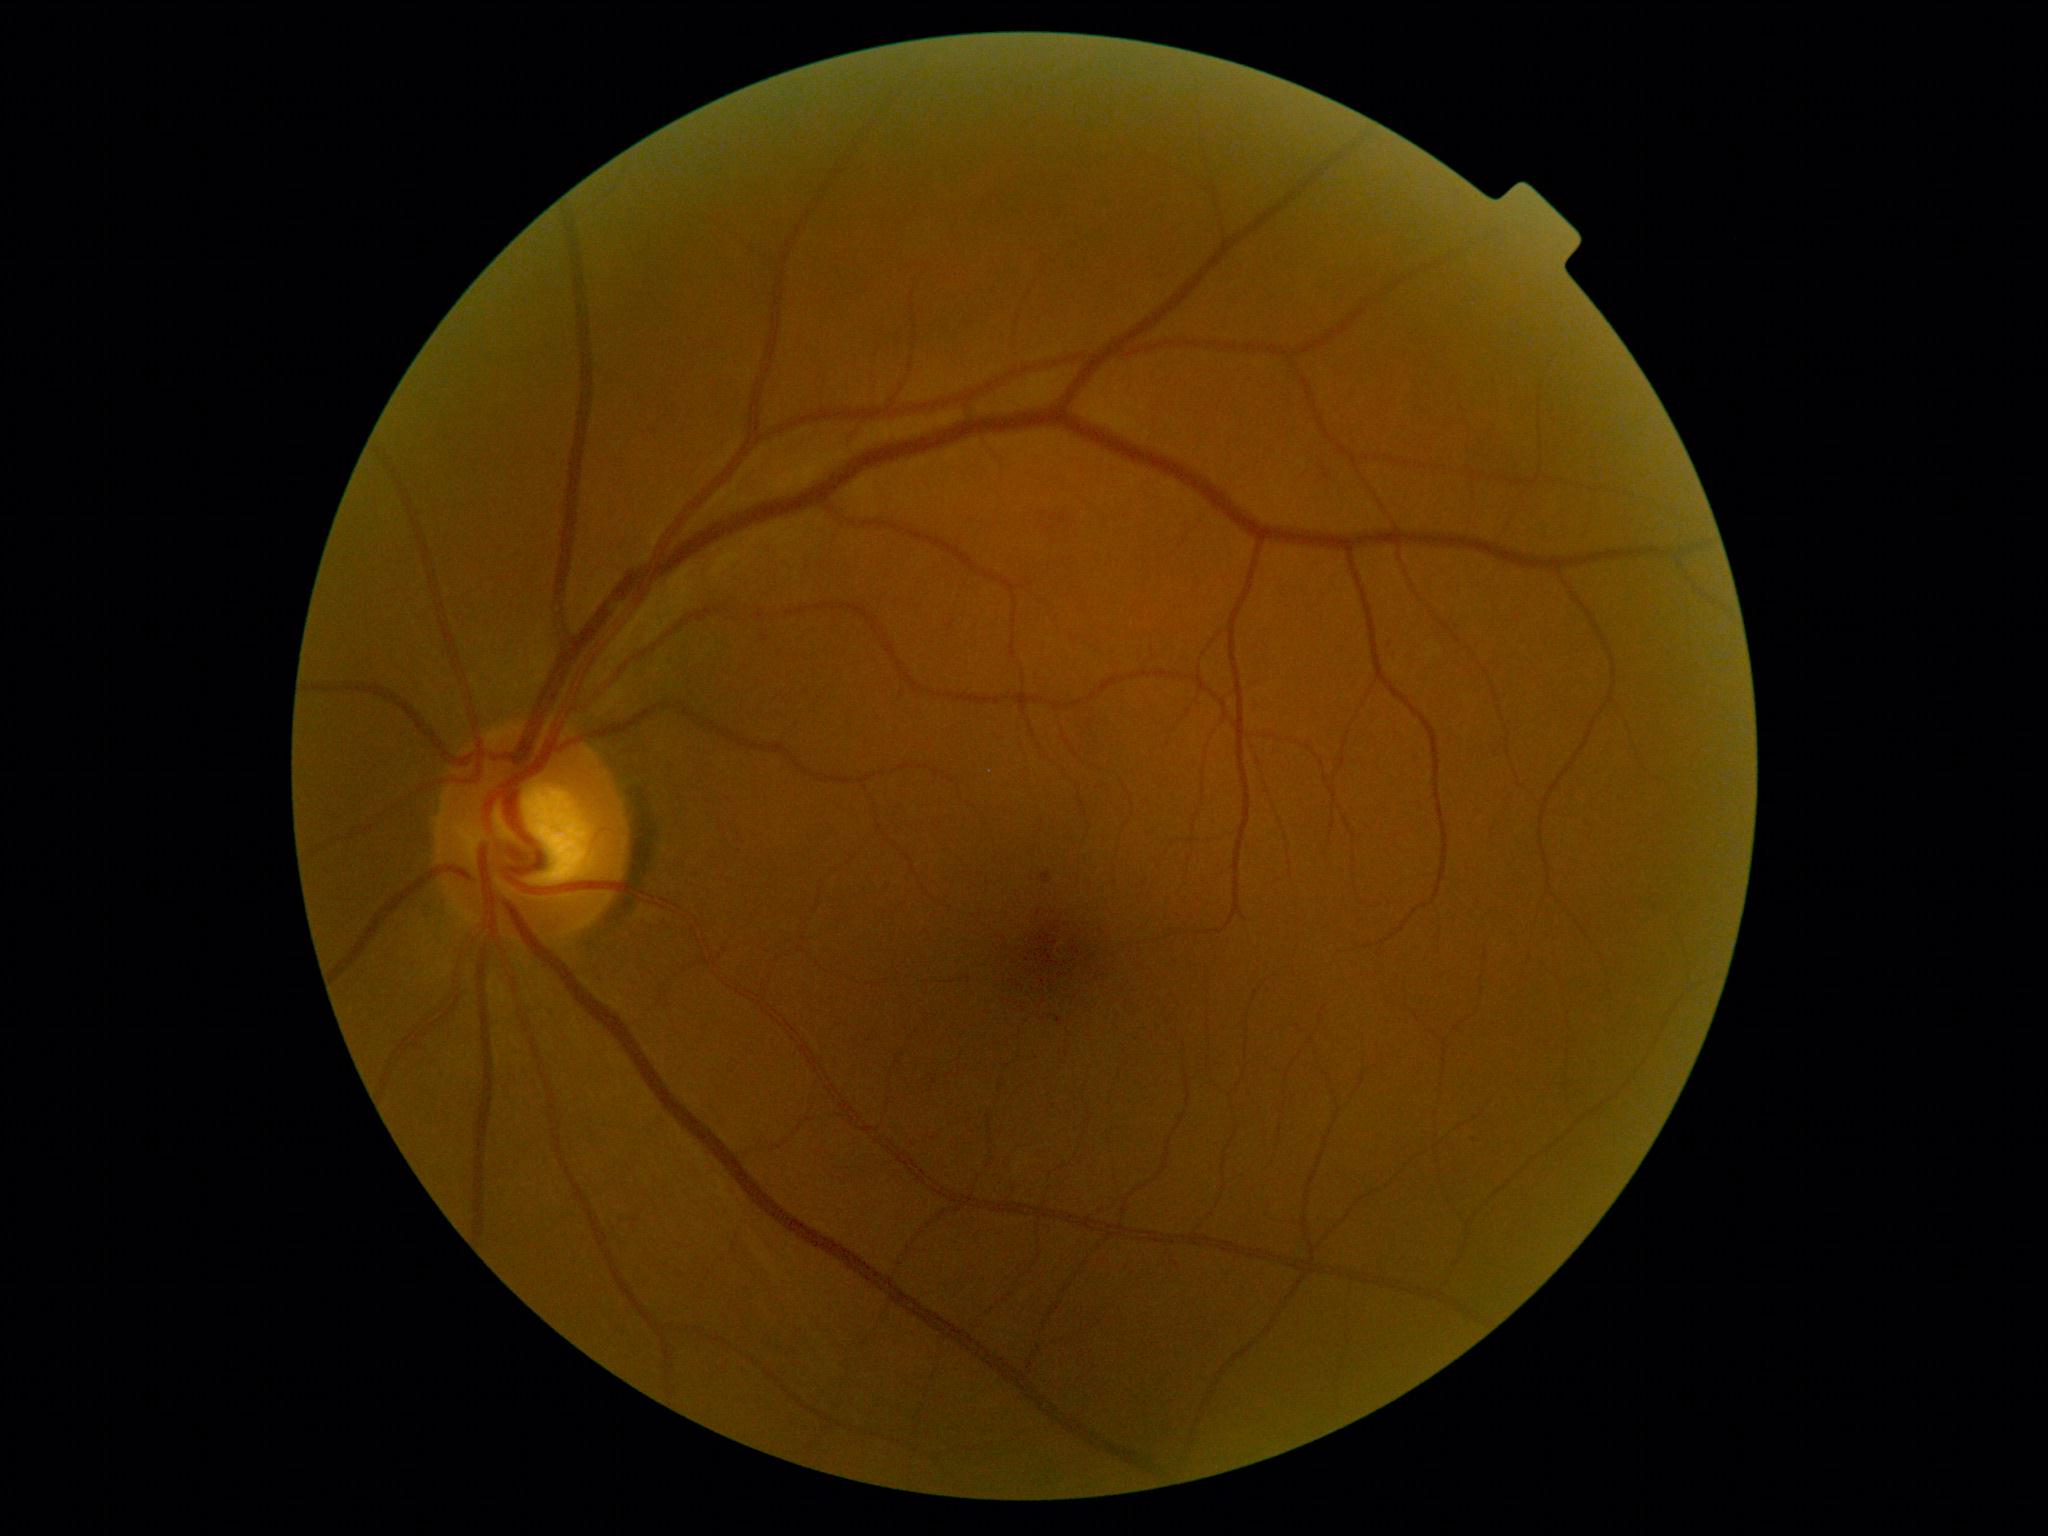
Diabetic retinopathy (DR): 1 — presence of microaneurysms only.